Topcon TRC-50DX: 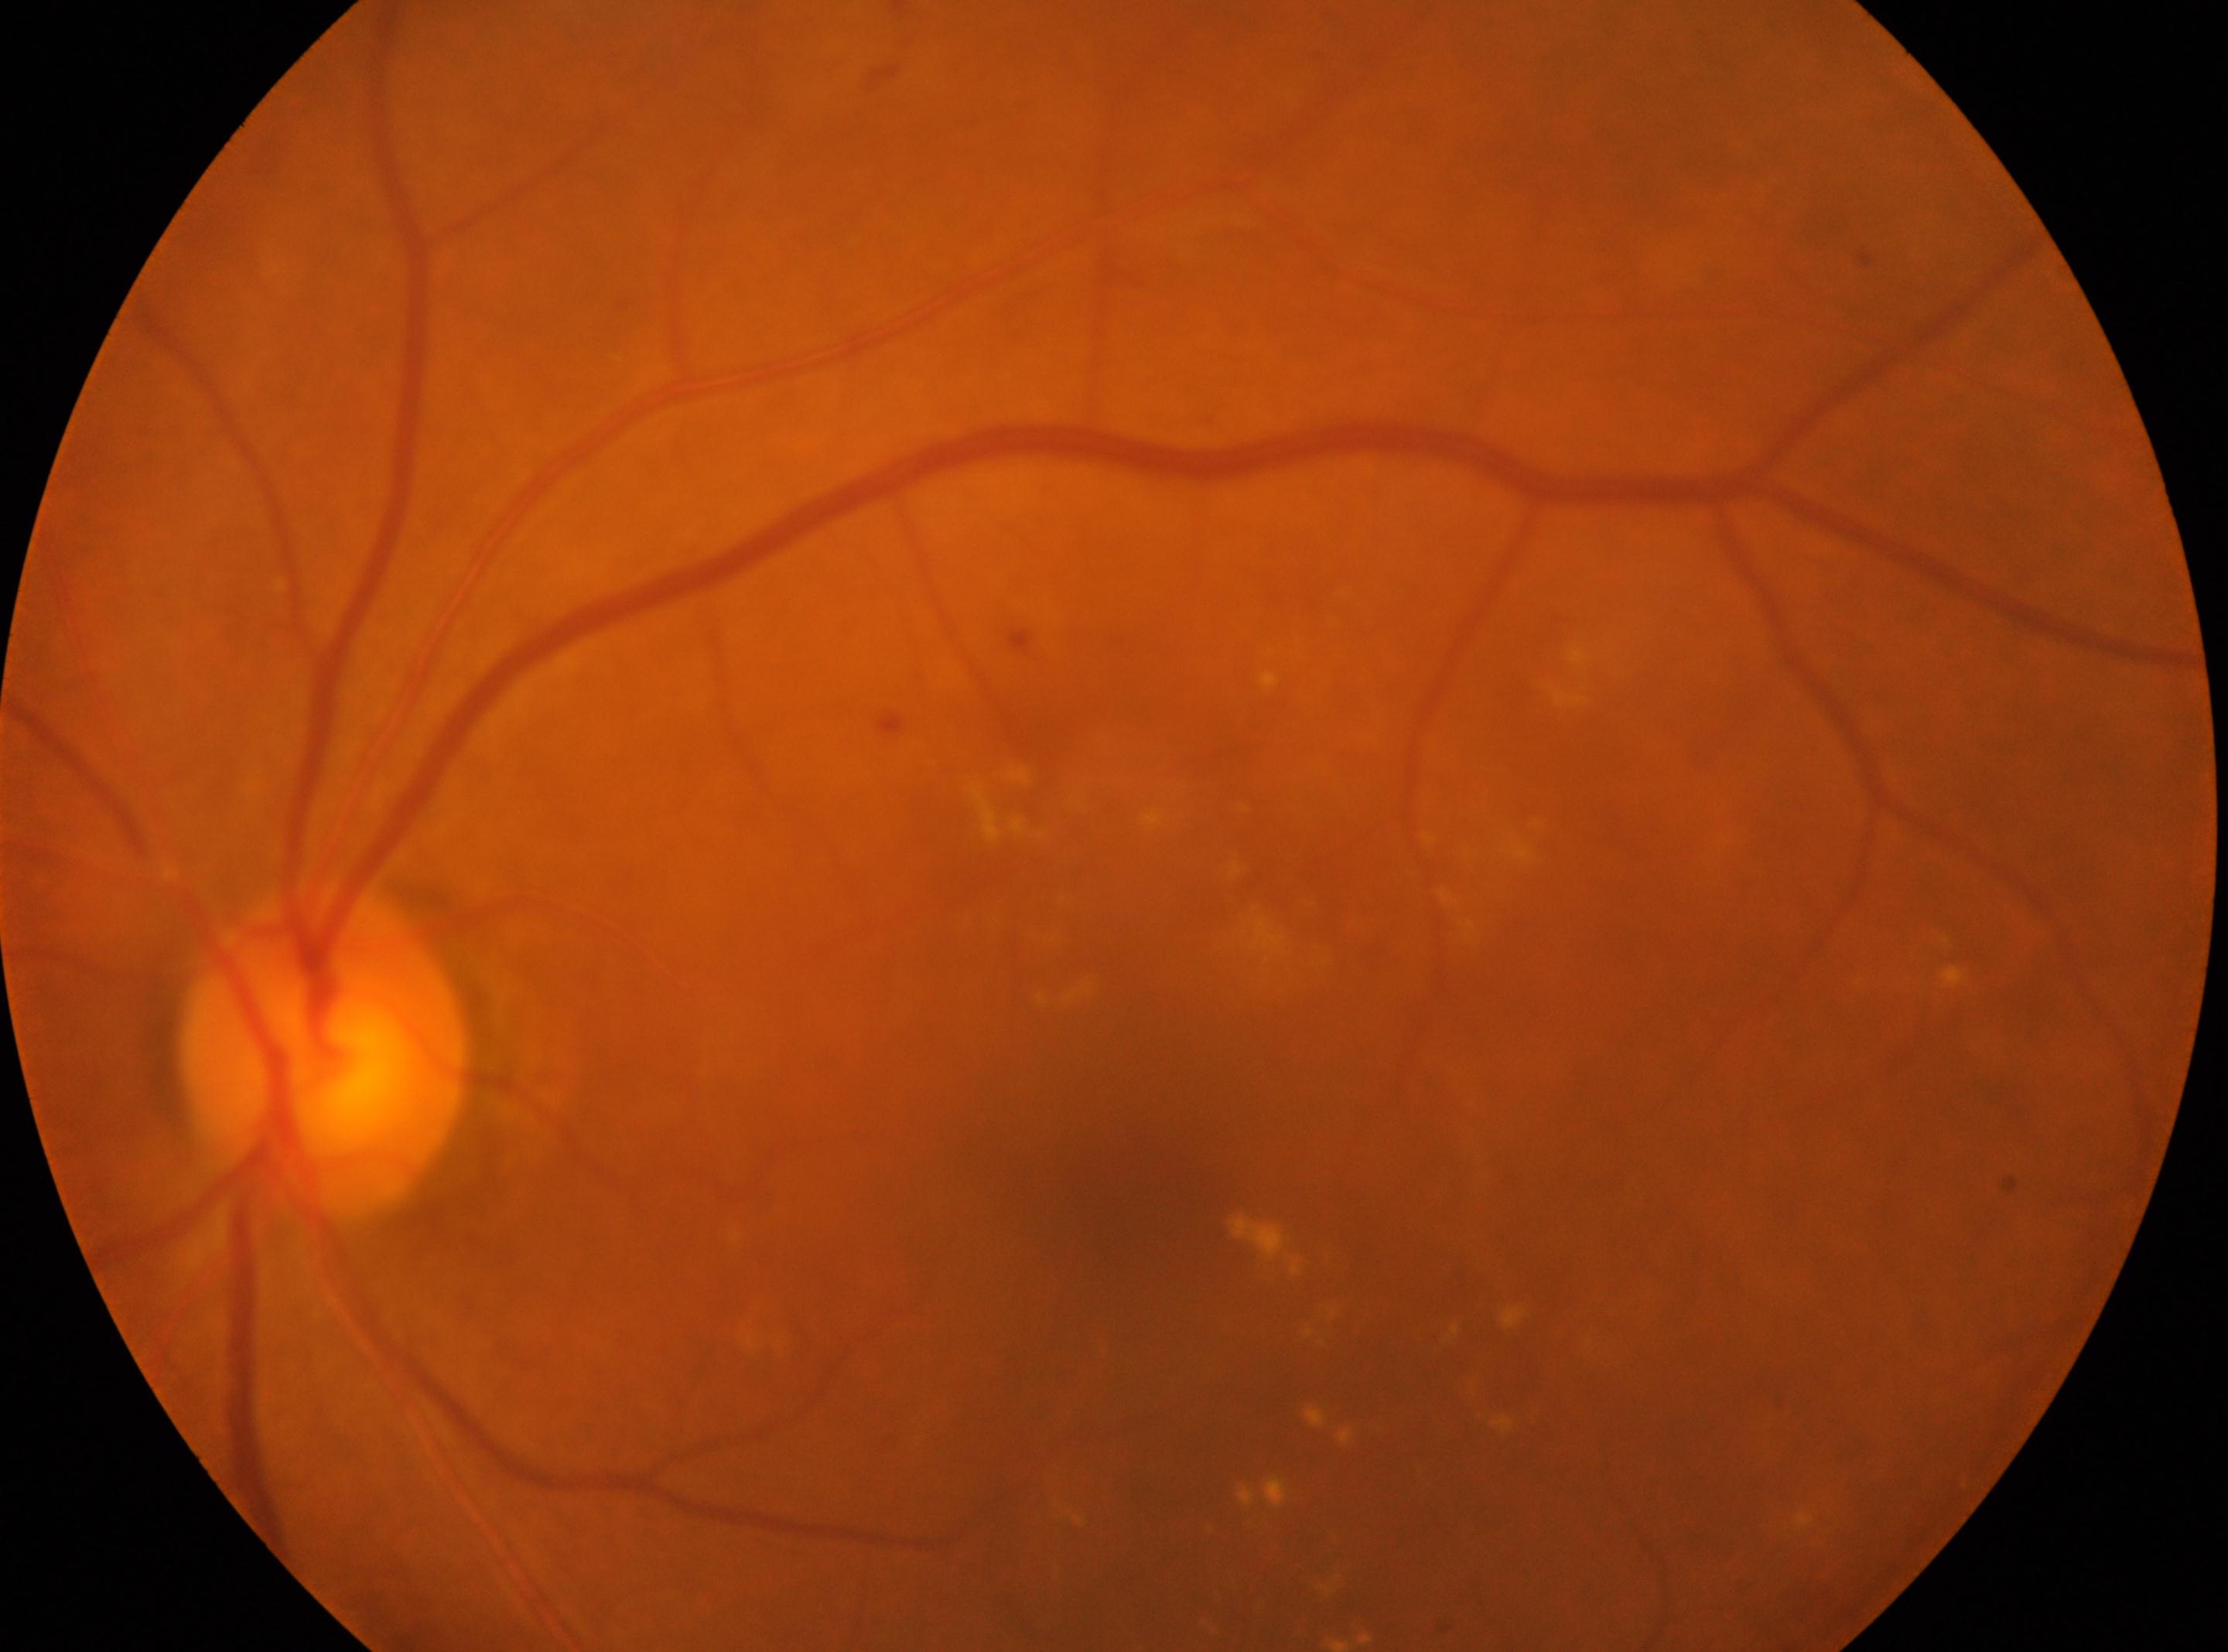
diabetic retinopathy (DR)@moderate non-proliferative diabetic retinopathy (grade 2) | left eye | macula center@(x: 1134, y: 1213) | ONH@(x: 325, y: 1056).